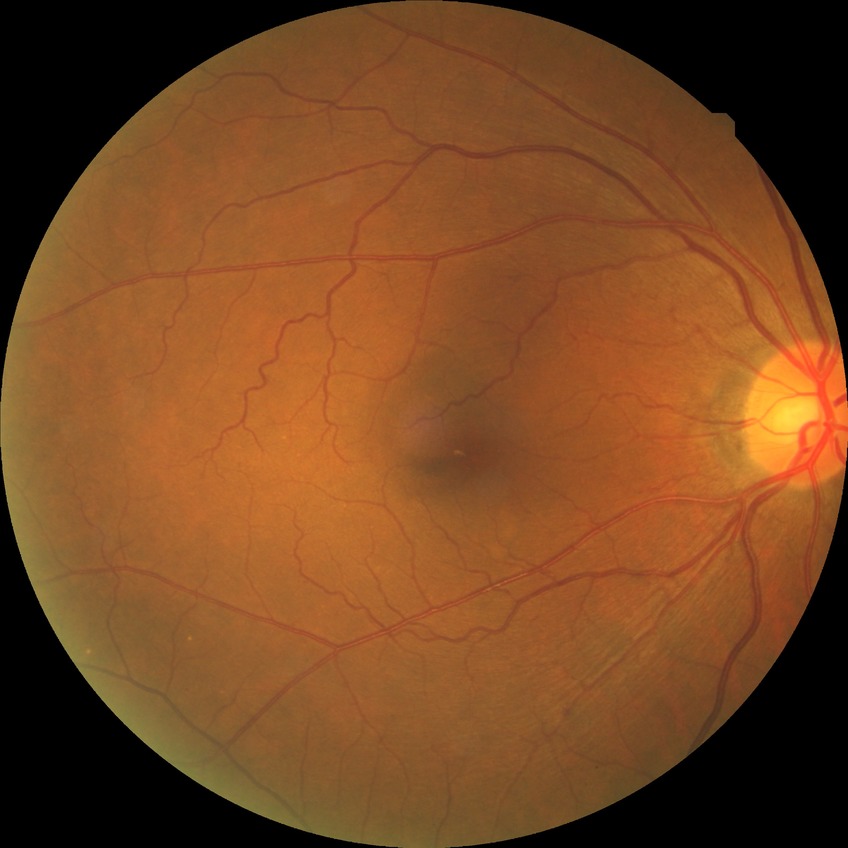
{
  "dr_impression": "negative for DR",
  "davis_grade": "NDR"
}